Fundus photo, 45 degree fundus photograph, Davis DR grading — 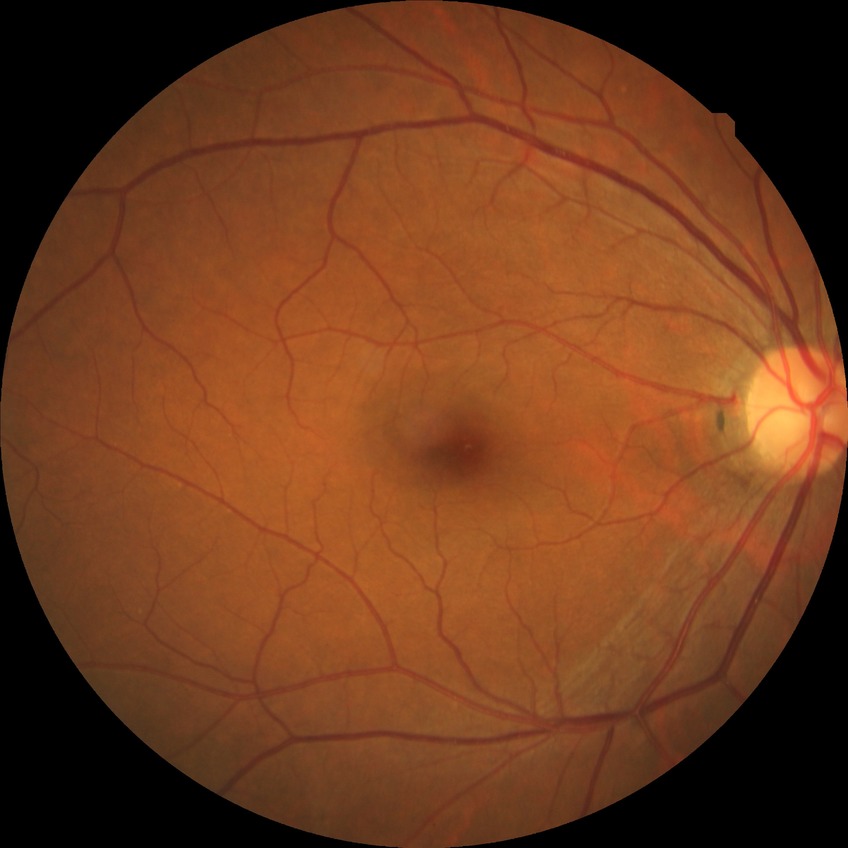
Diabetic retinopathy (DR): no diabetic retinopathy (NDR).